RetCam wide-field infant fundus image — 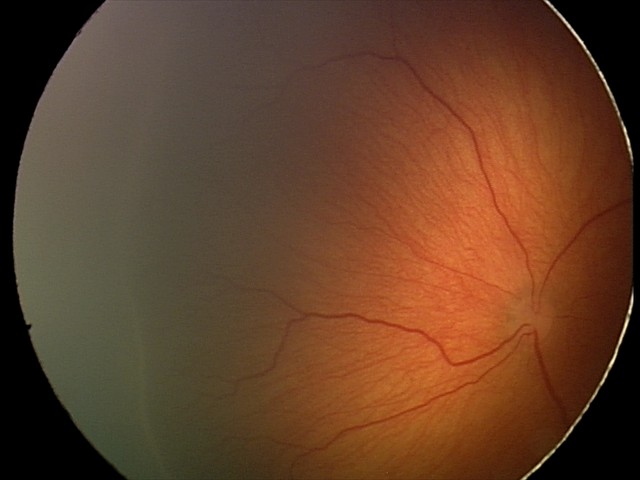
Series diagnosed as retinopathy of prematurity (ROP) stage 2. Without plus disease.